Posterior pole color fundus photograph; modified Davis classification — 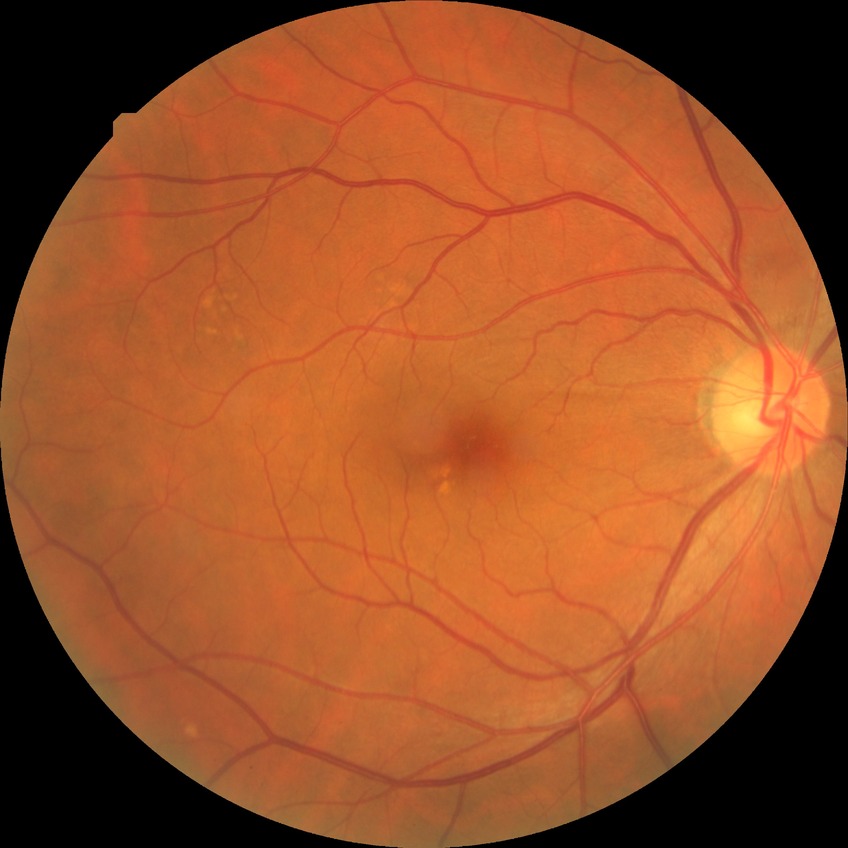 No apparent diabetic retinopathy.
DR severity is NDR.